640x480px. Wide-field fundus photograph from neonatal ROP screening. Captured with the Clarity RetCam 3 (130° field of view): 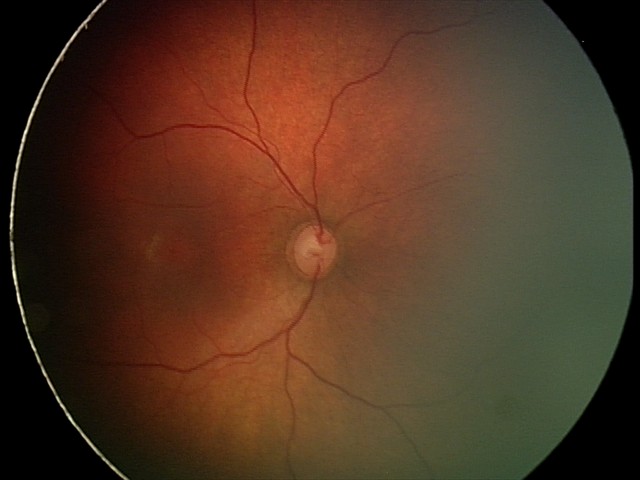 Assessment: physiological.